CFP. 45° FOV.
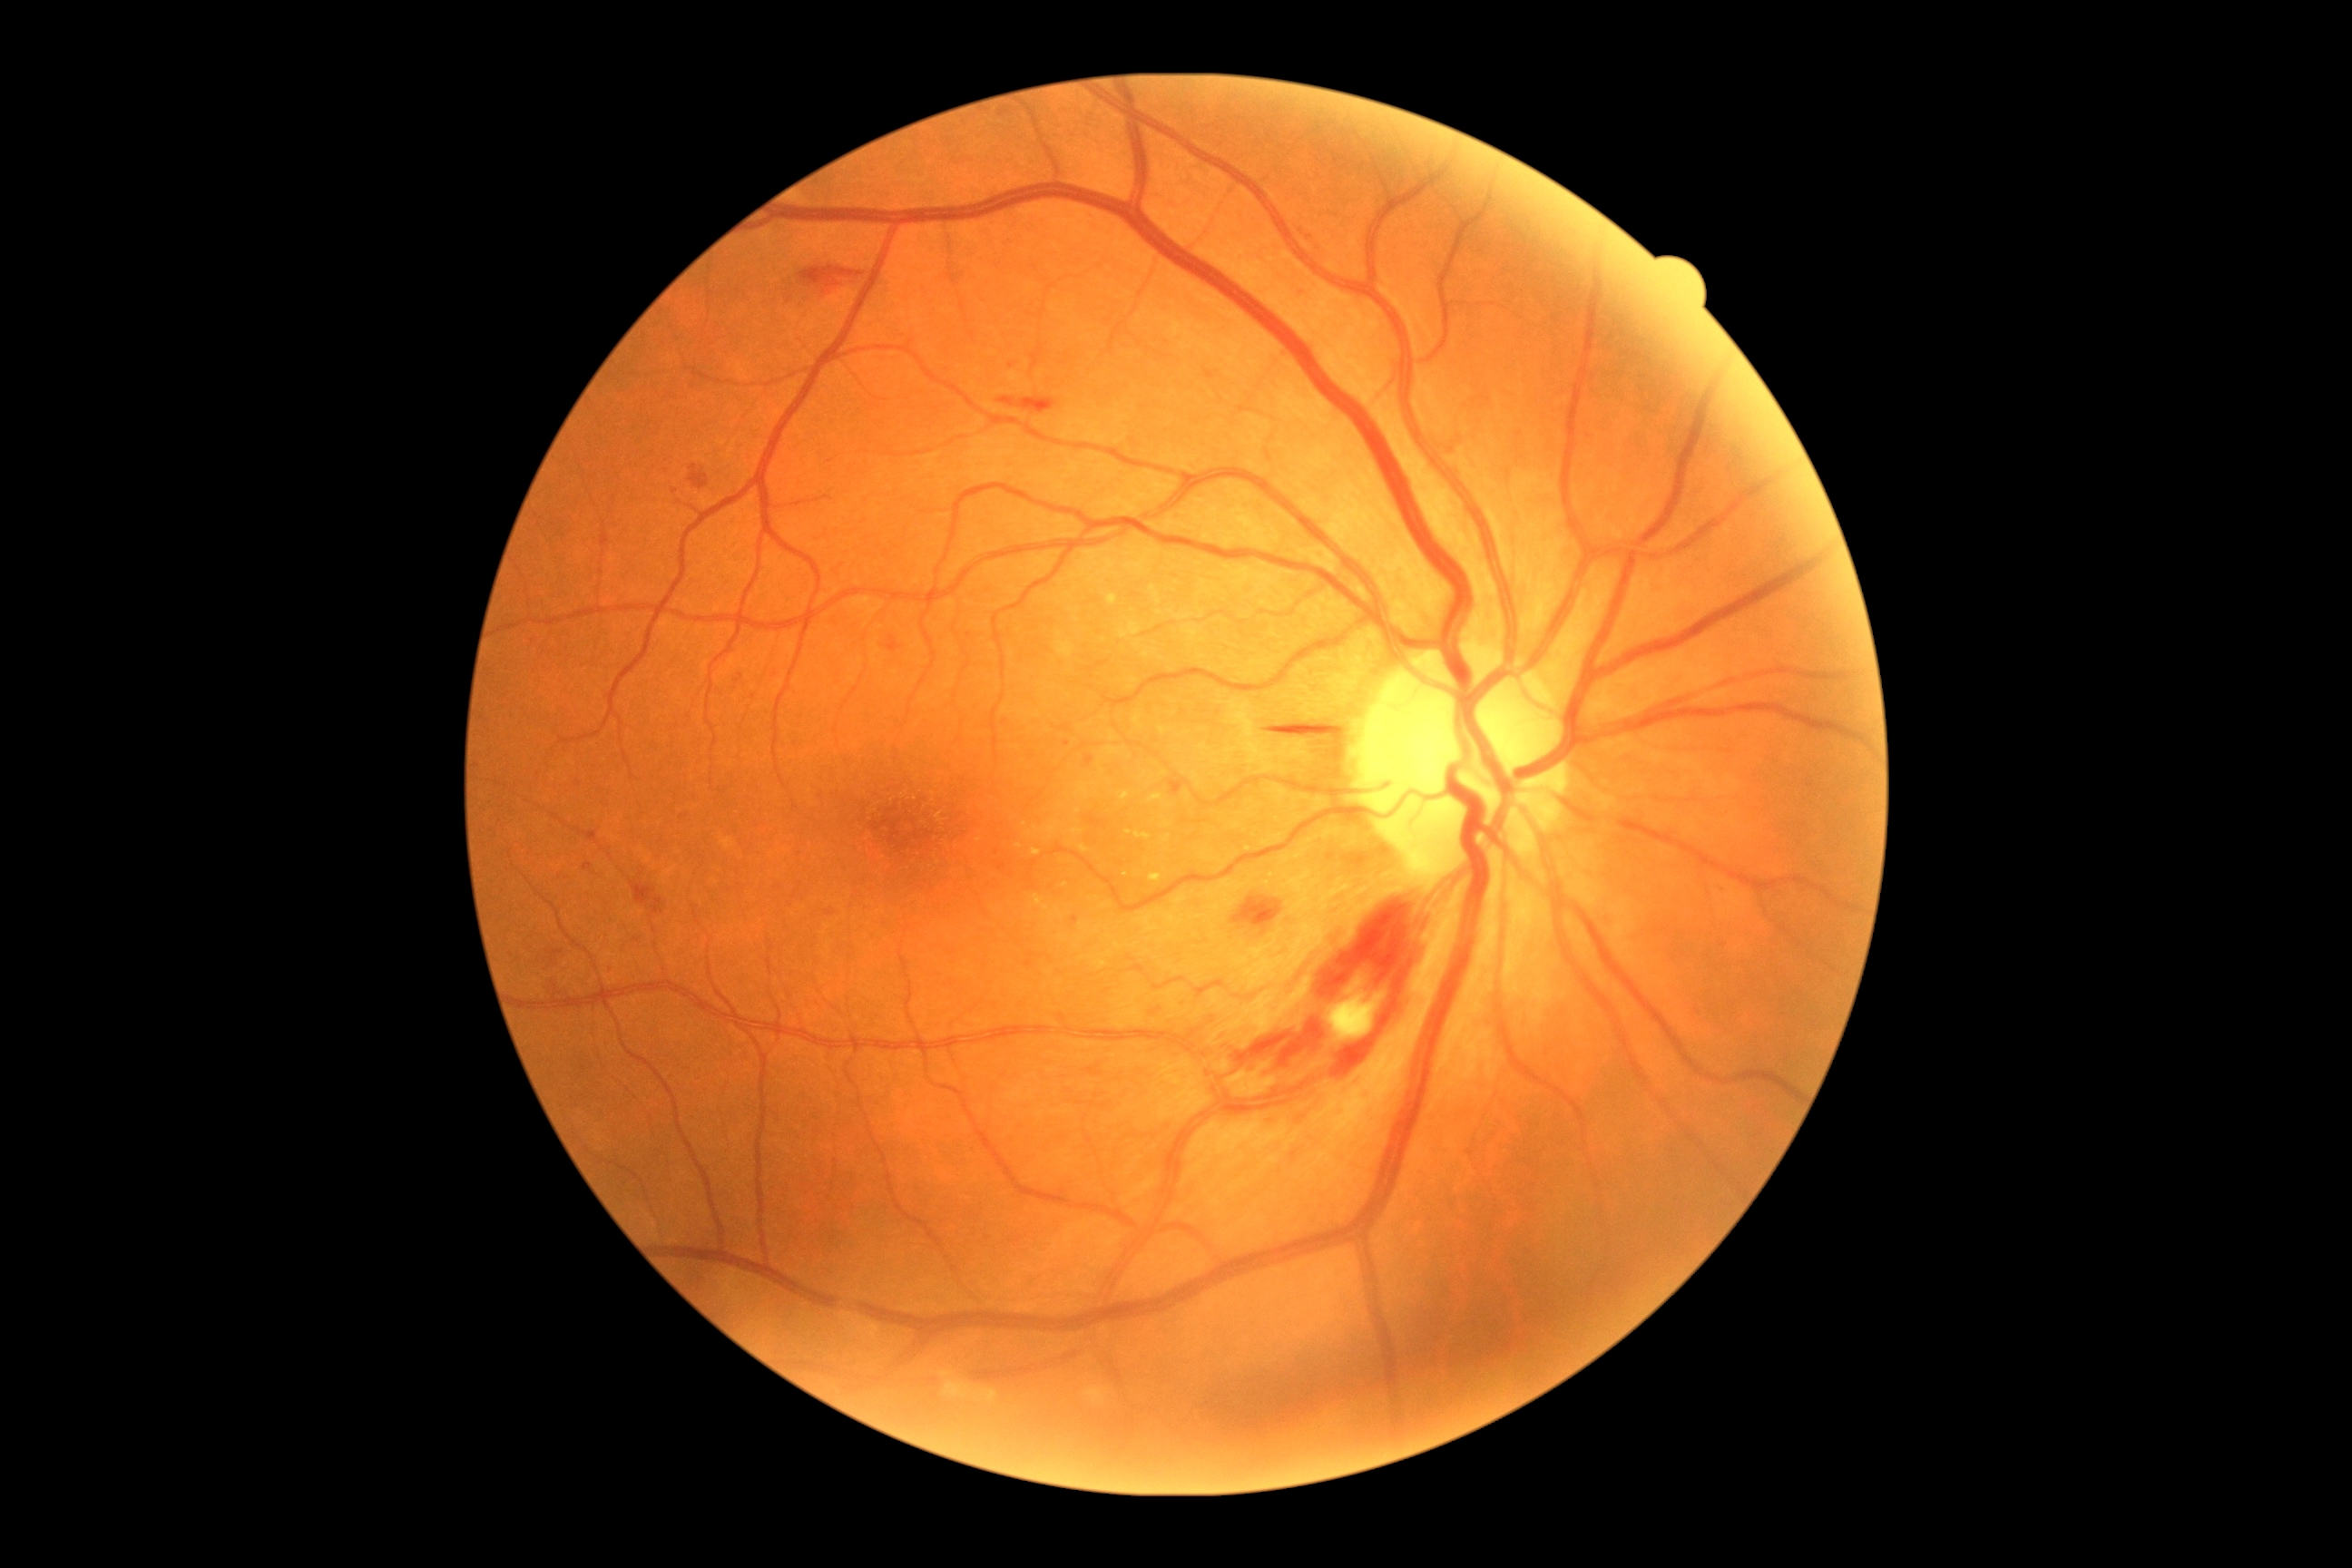

DR class: non-proliferative diabetic retinopathy | diabetic retinopathy (DR): grade 2 (moderate NPDR).